Image size 848x848, graded on the modified Davis scale: 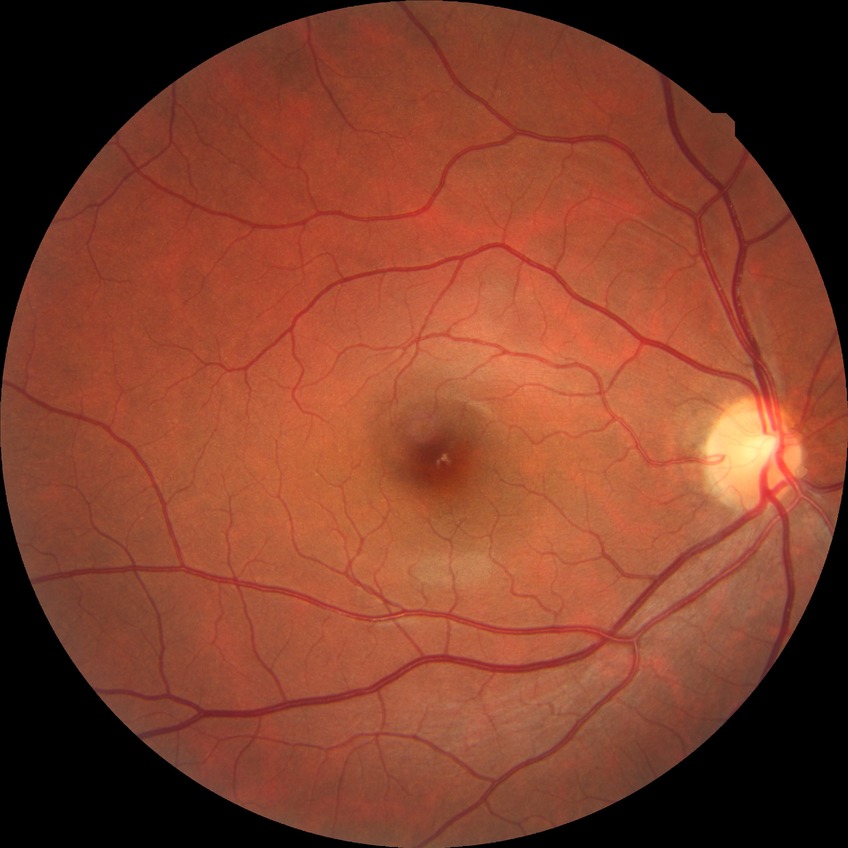

Diabetic retinopathy severity: no diabetic retinopathy.